Image size 2352x1568. FOV: 45 degrees. Retinal fundus photograph:
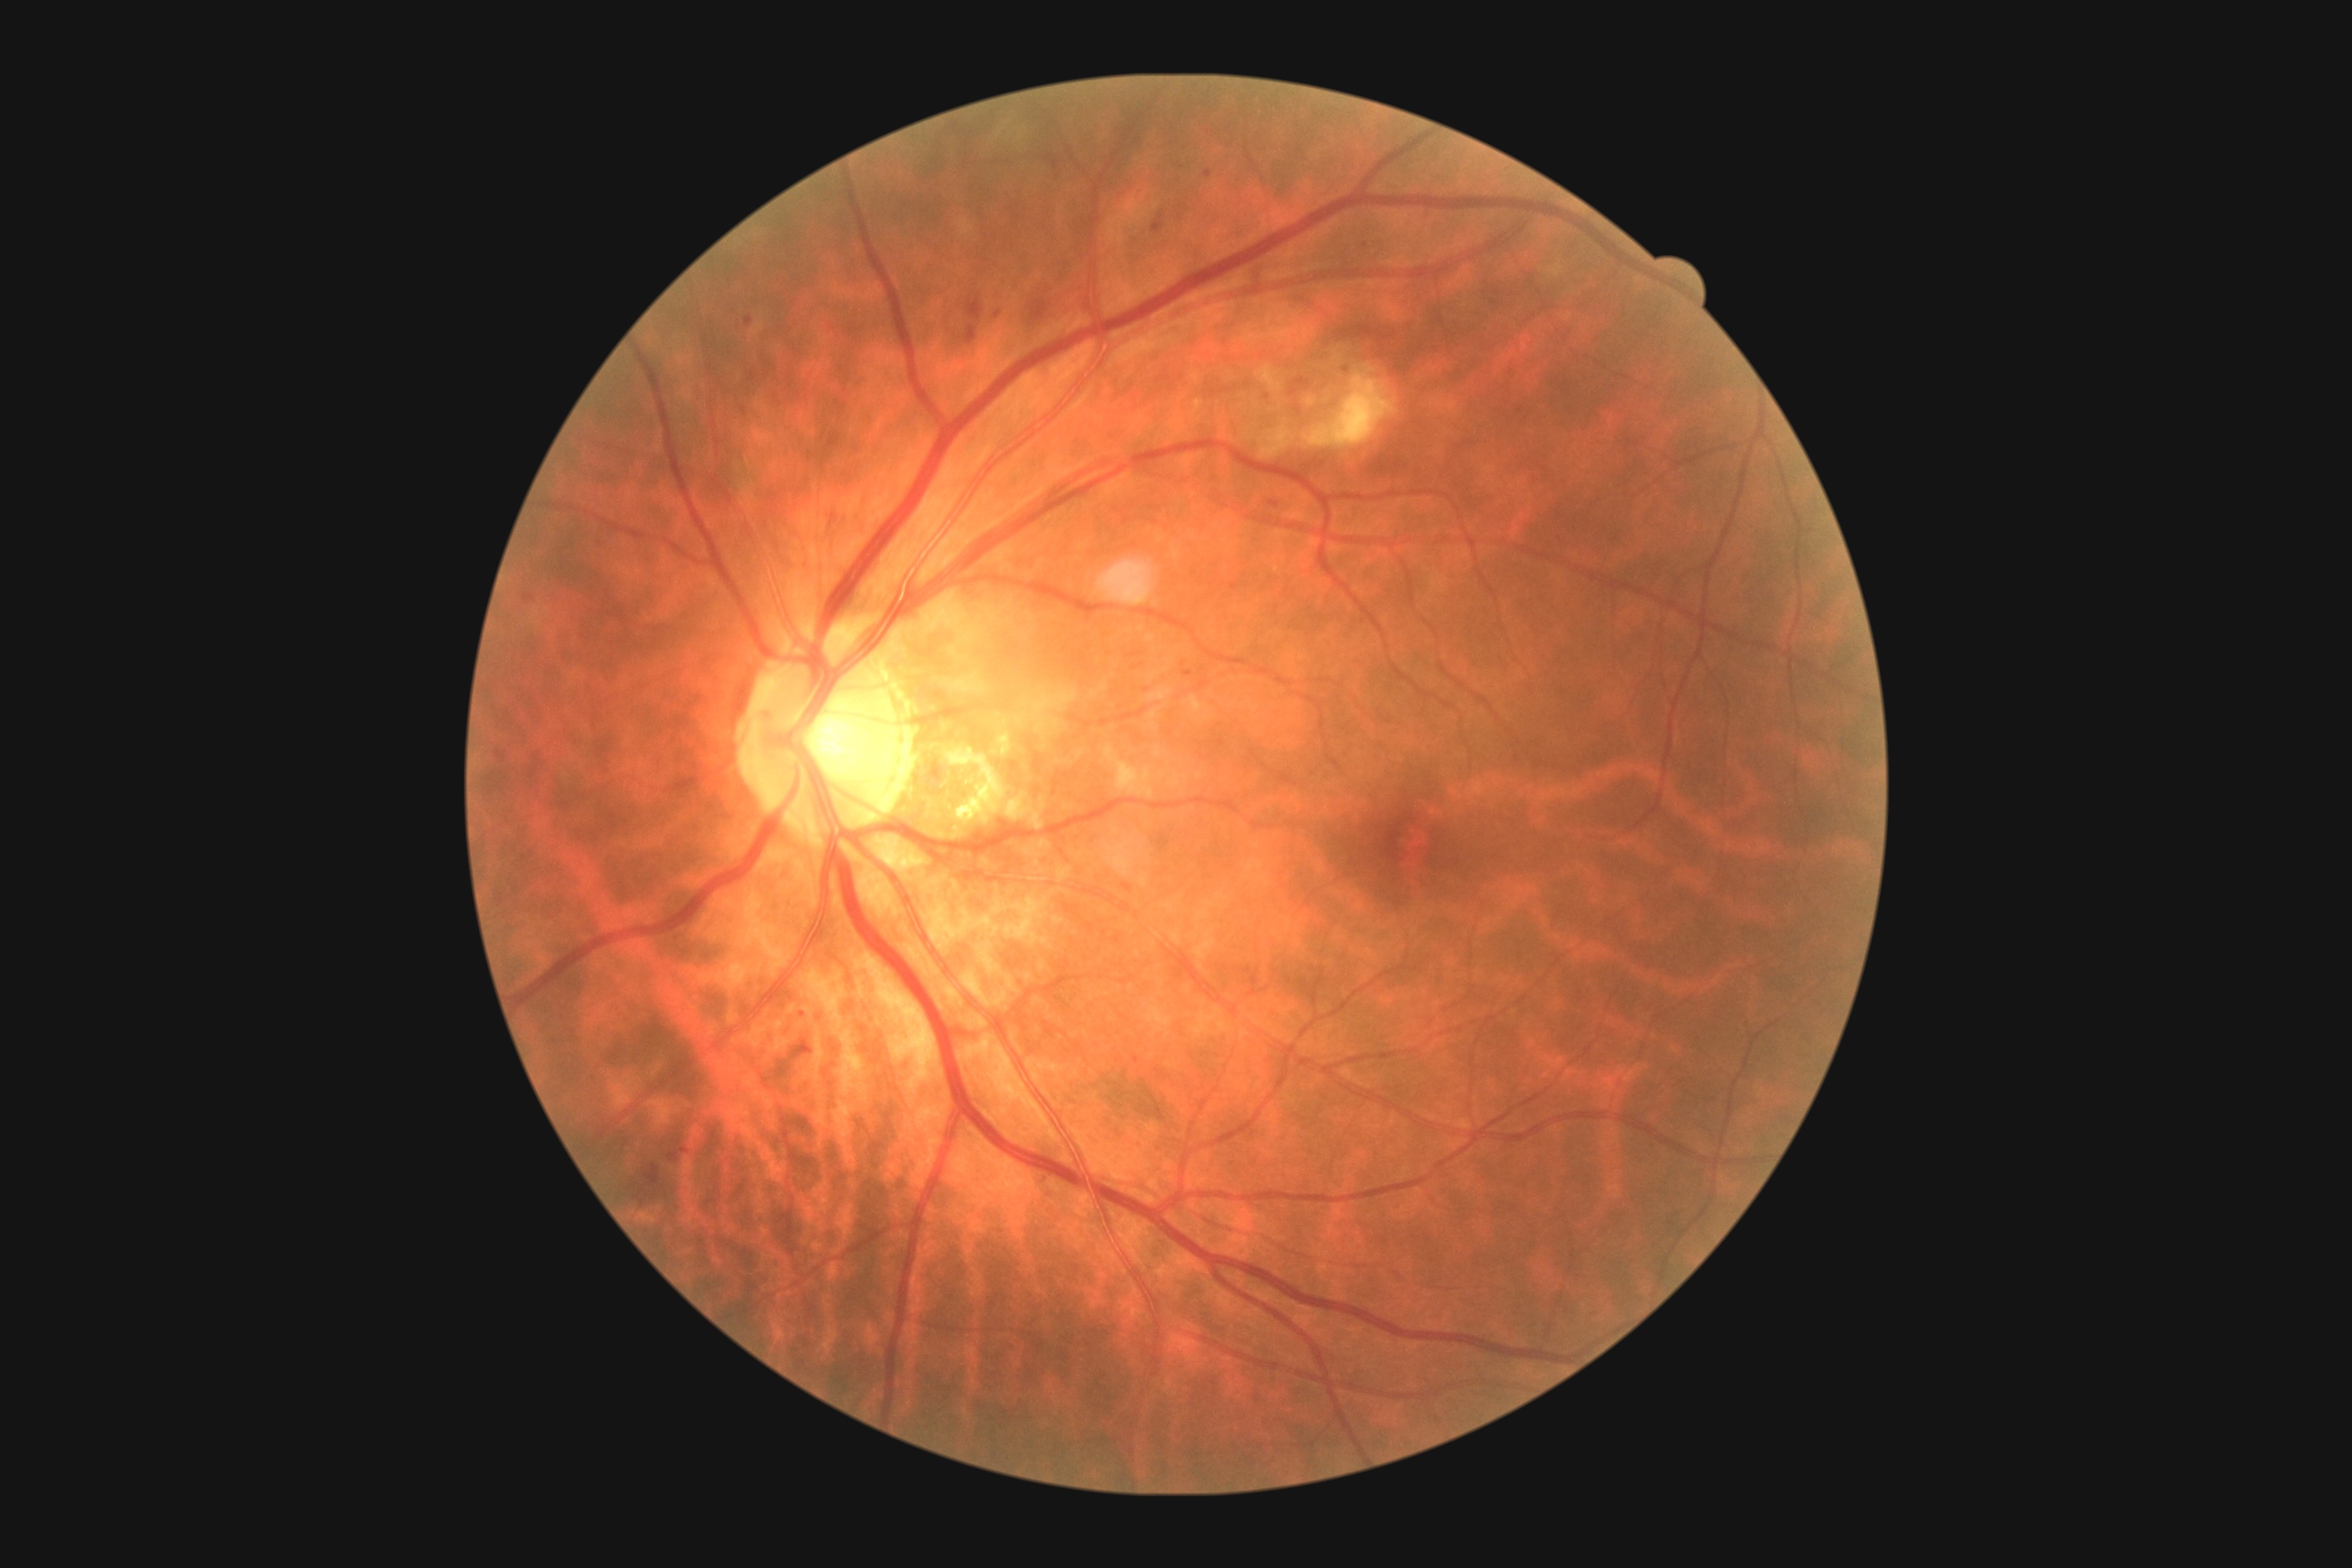
diabetic retinopathy: moderate NPDR (grade 2) | DR class: non-proliferative diabetic retinopathy.